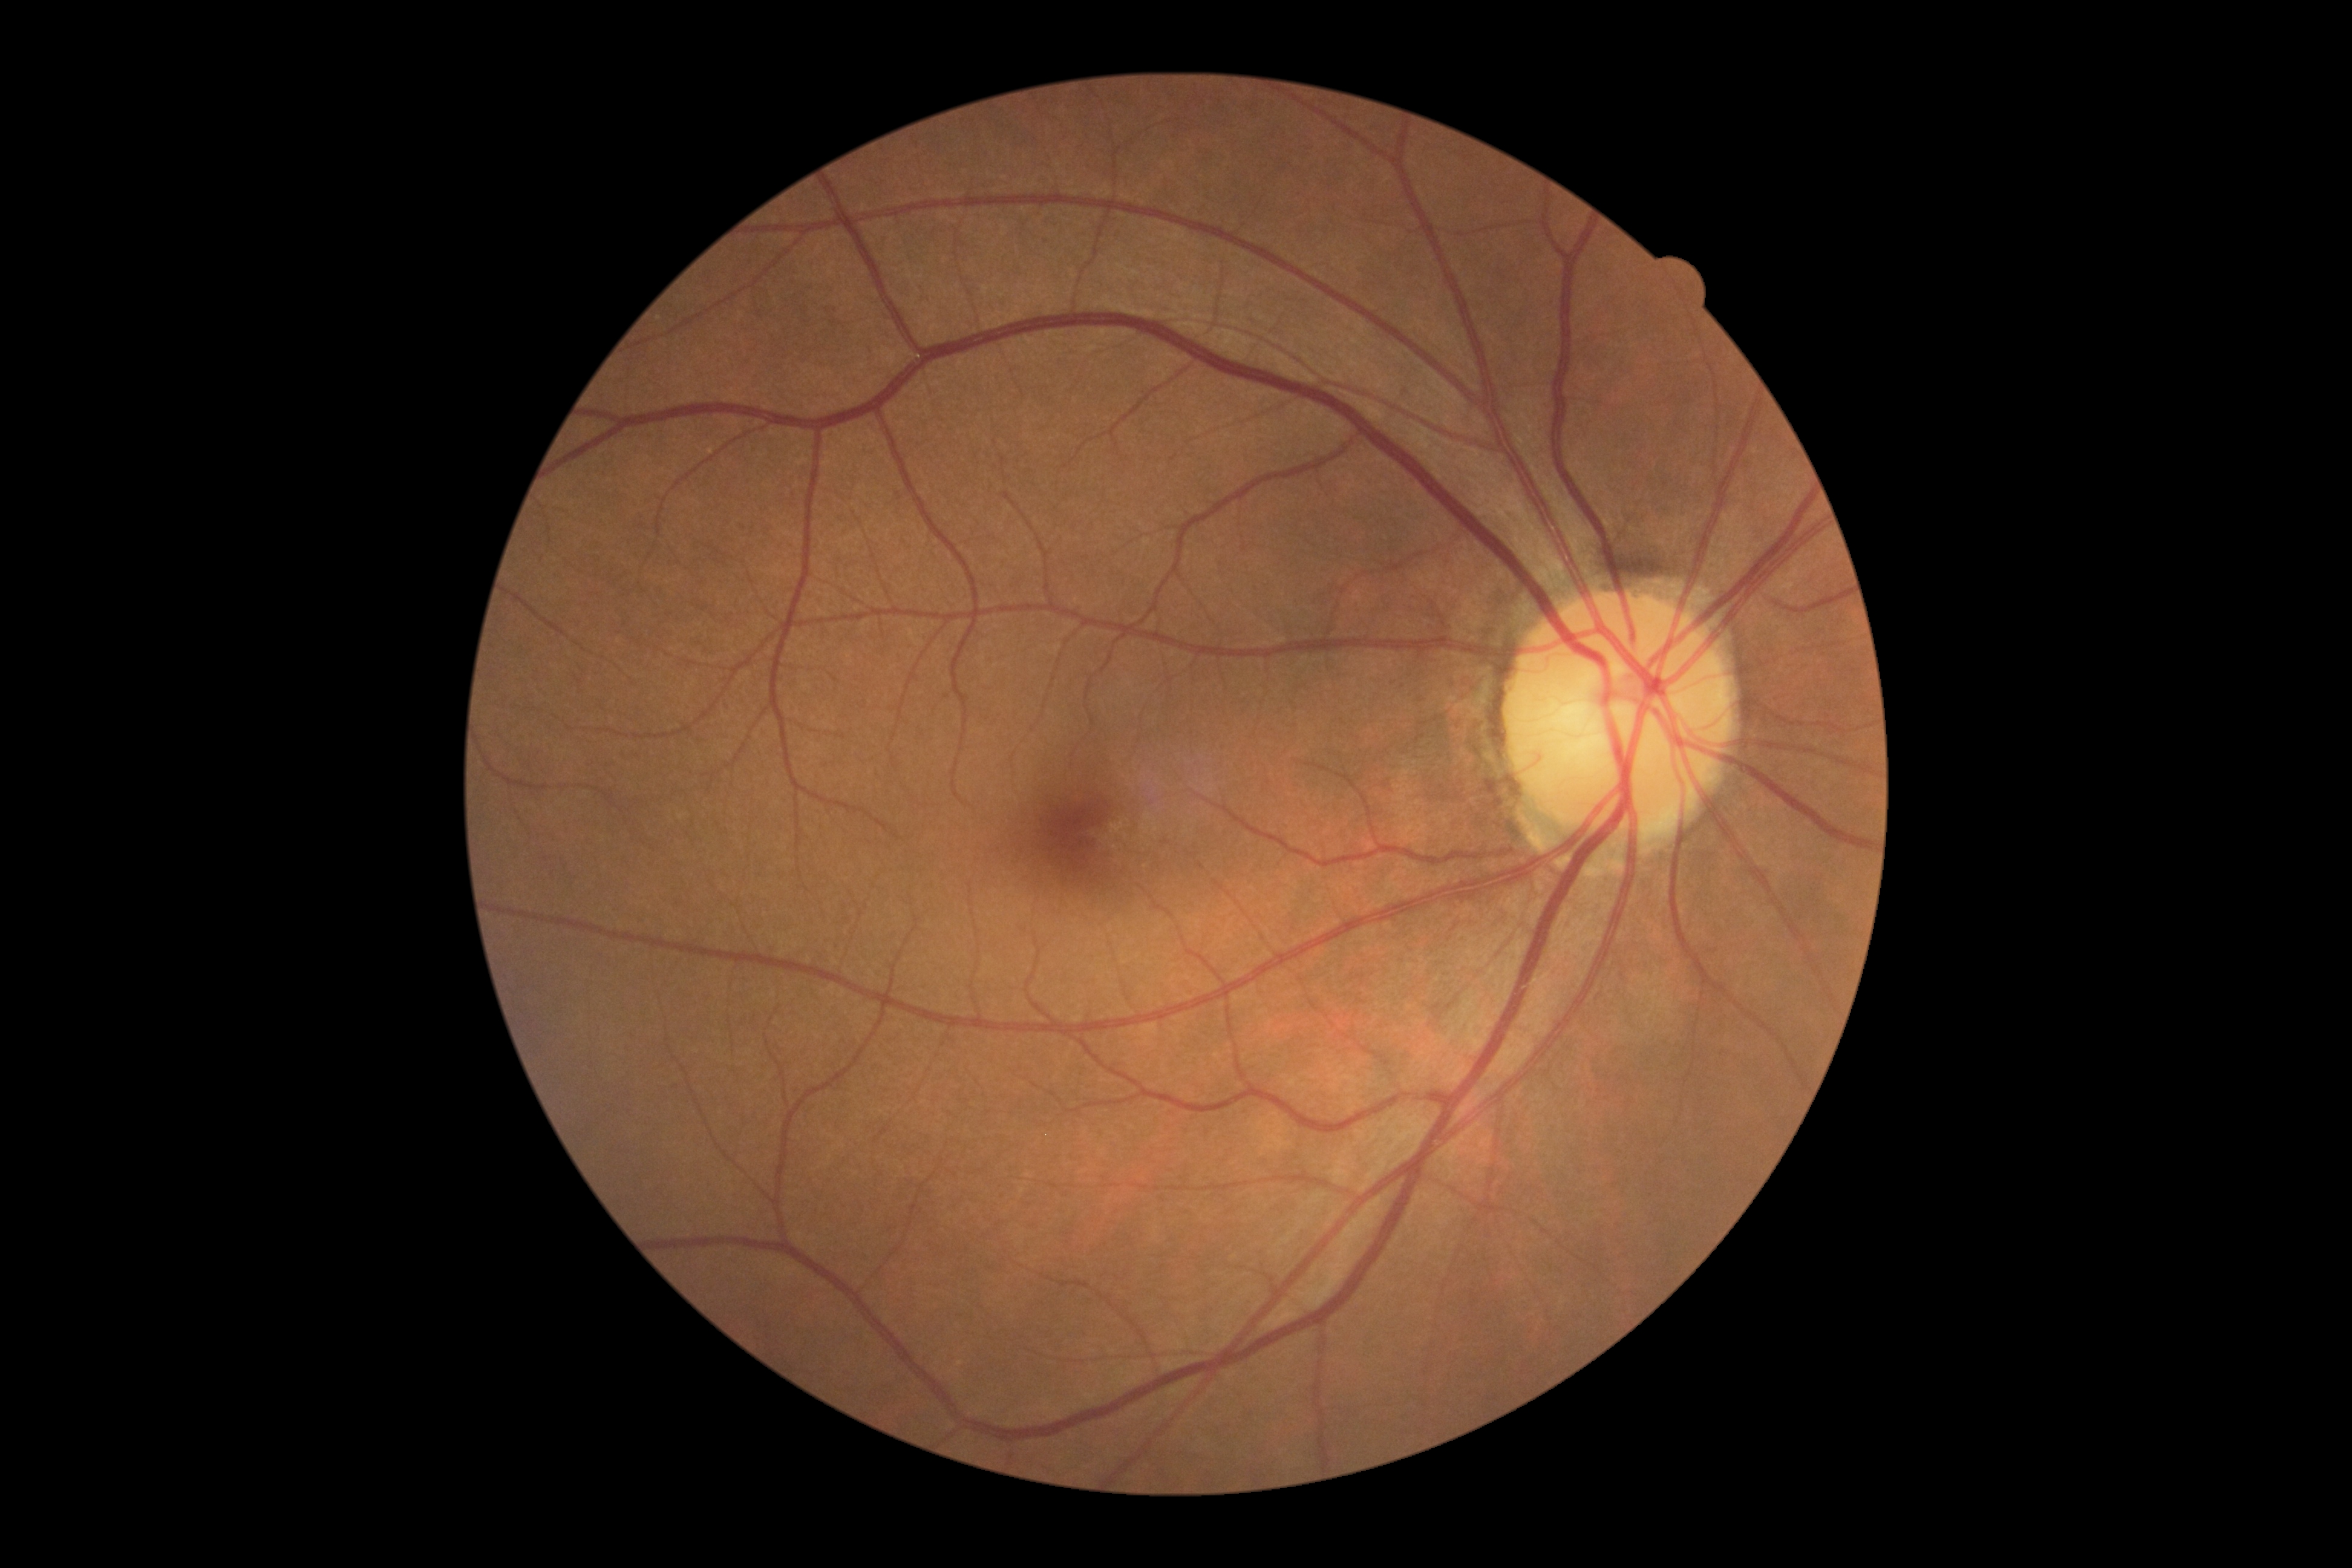
DR severity is grade 0 (no apparent retinopathy) — no visible signs of diabetic retinopathy.